Diabetic retinopathy graded by the modified Davis classification; 848 x 848 pixels.
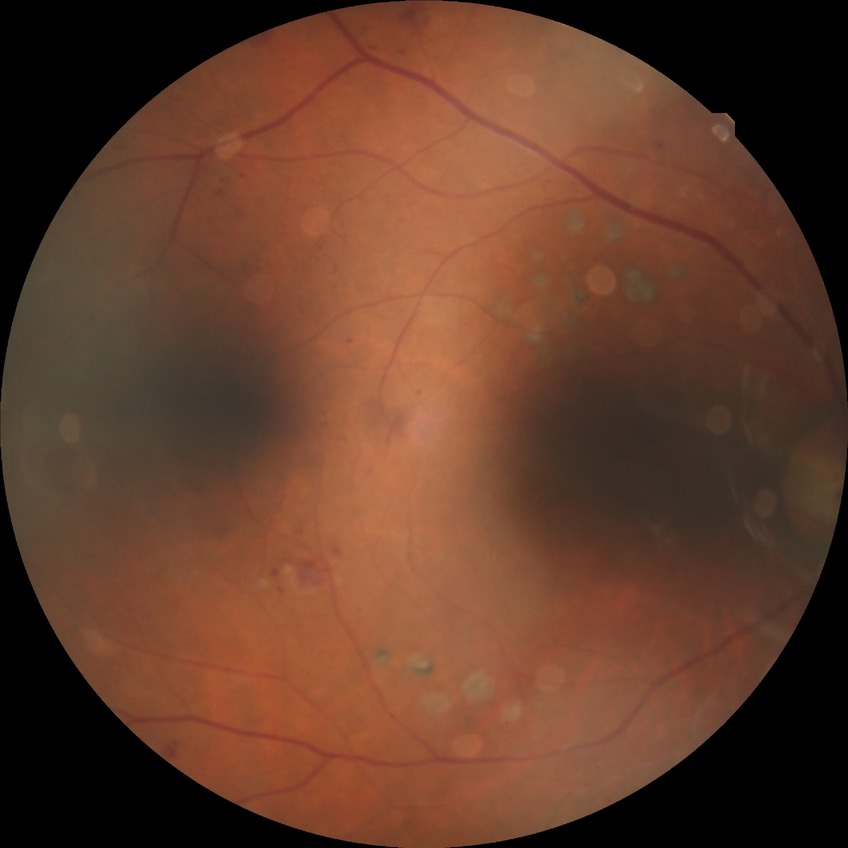
– modified Davis classification: proliferative diabetic retinopathy